45-degree field of view.
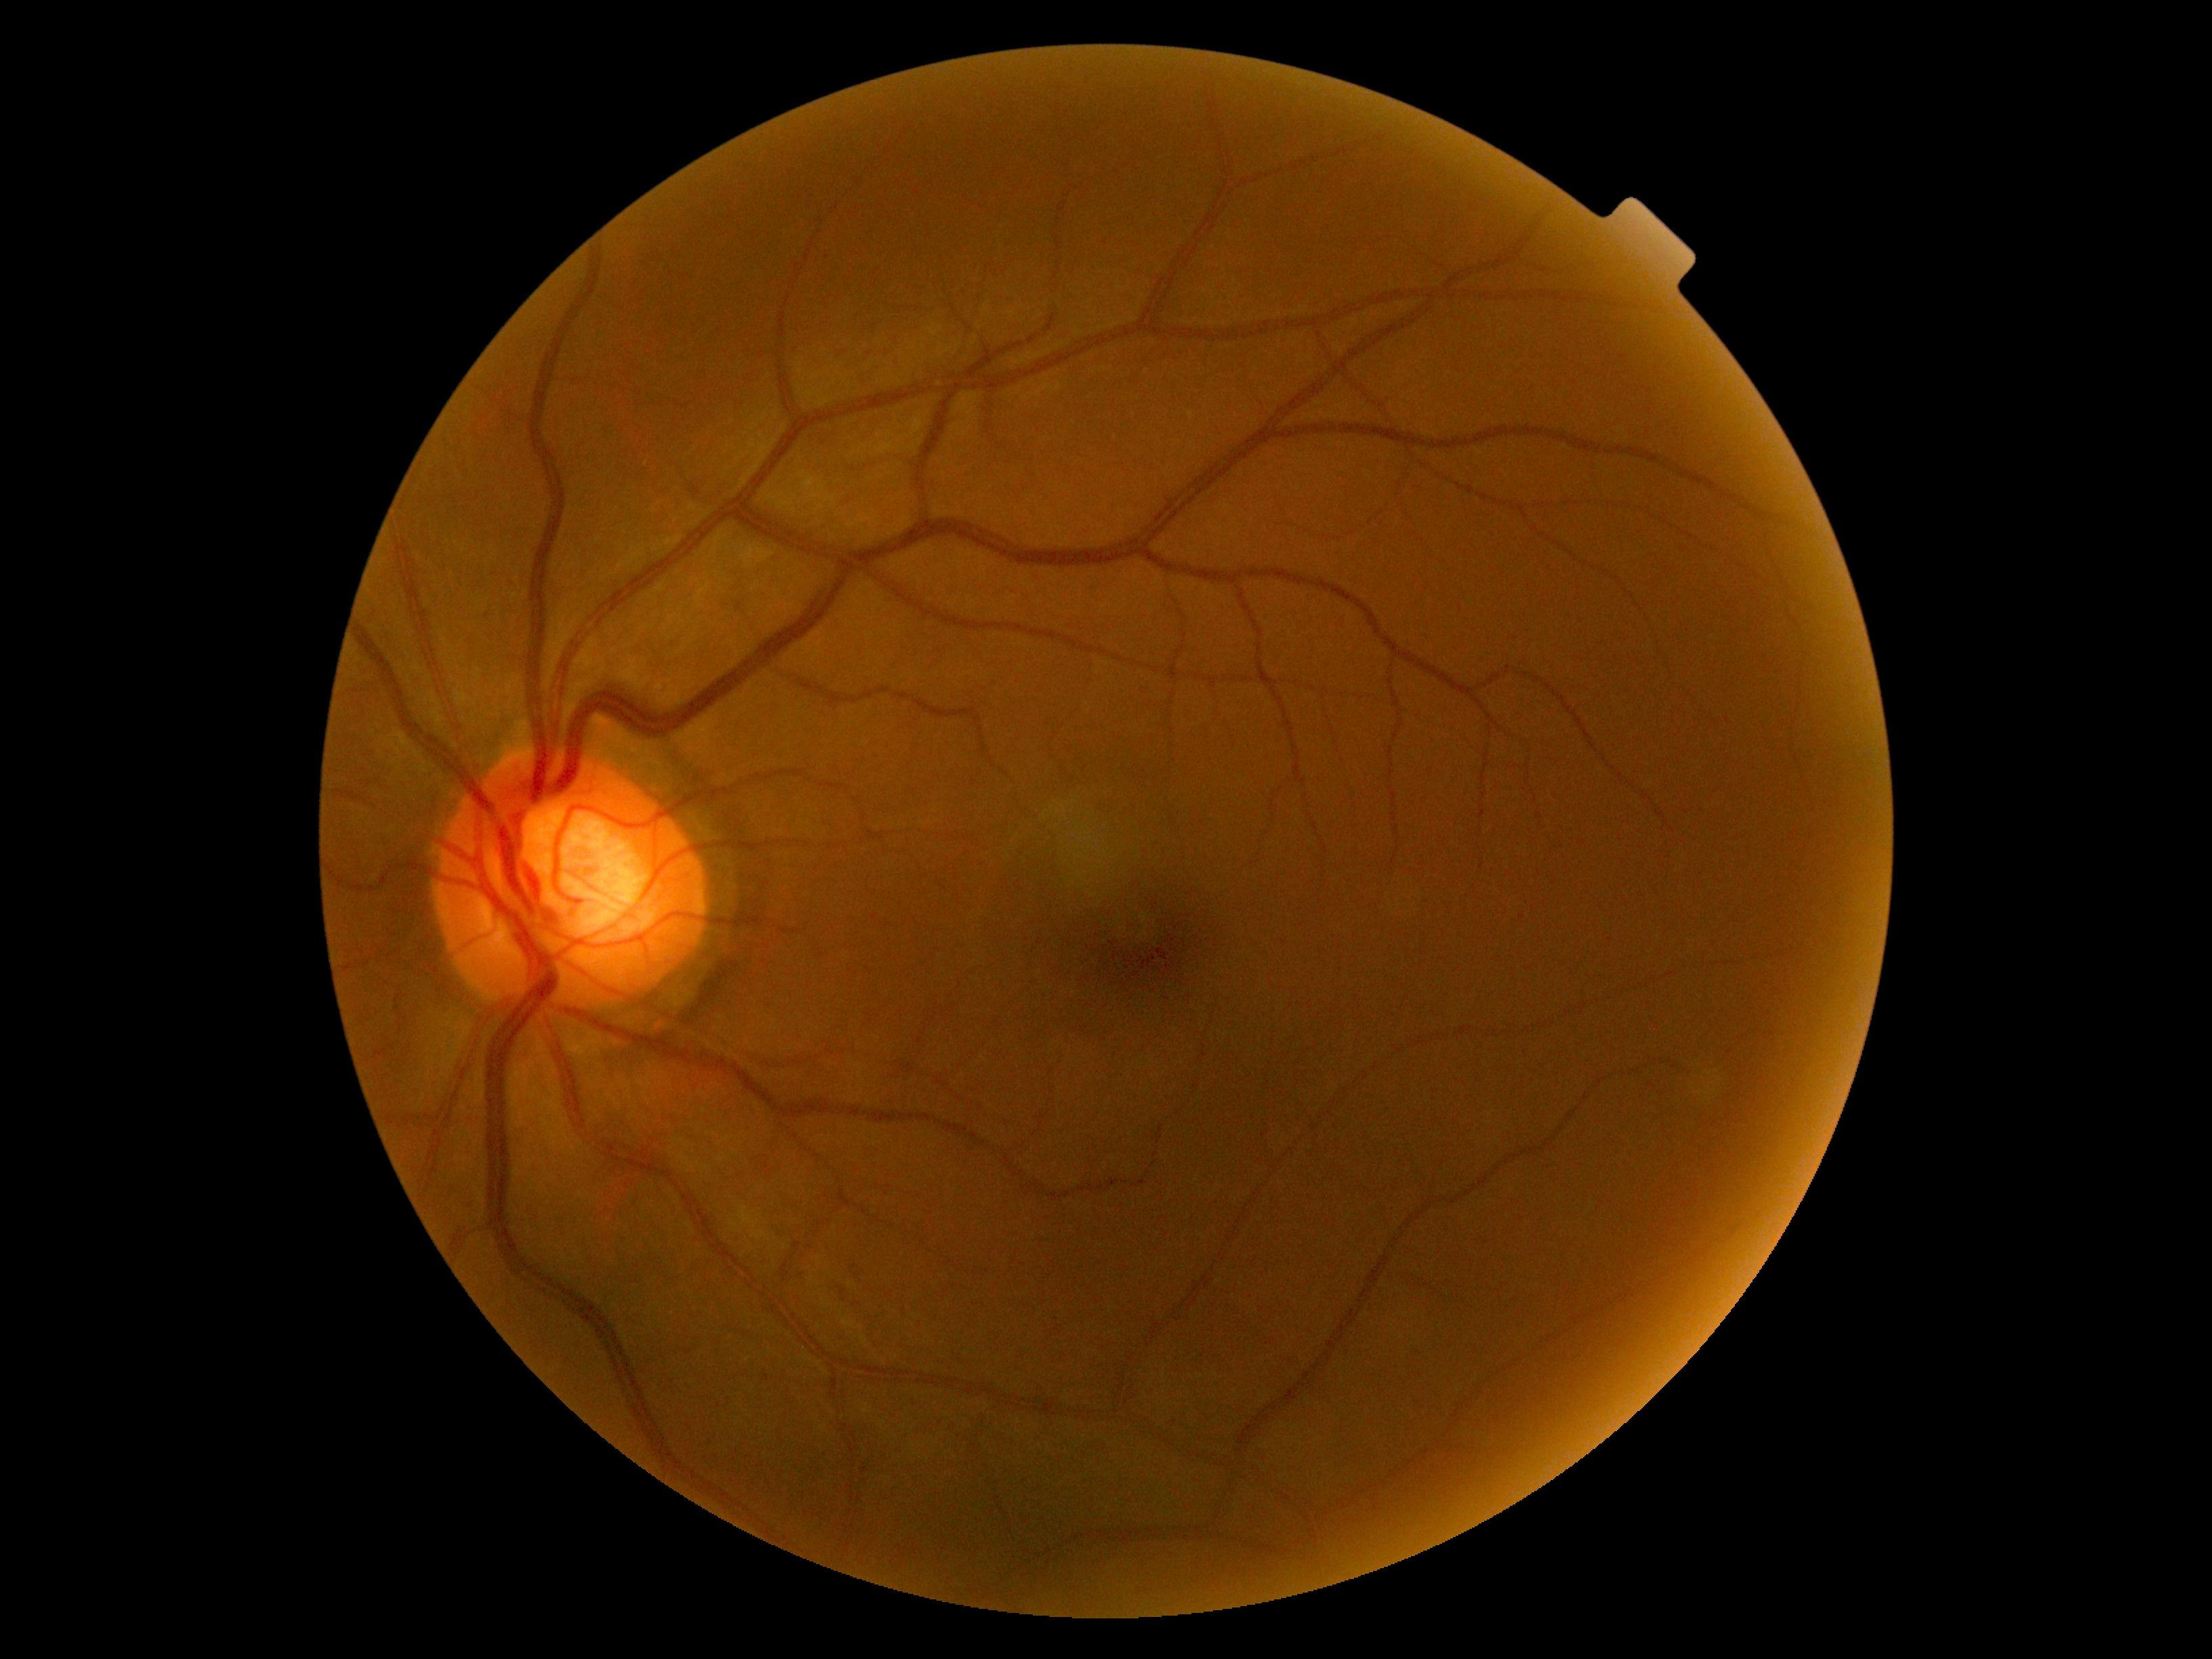
DR stage is grade 0.